2048x1536; color fundus image; 45° field of view — 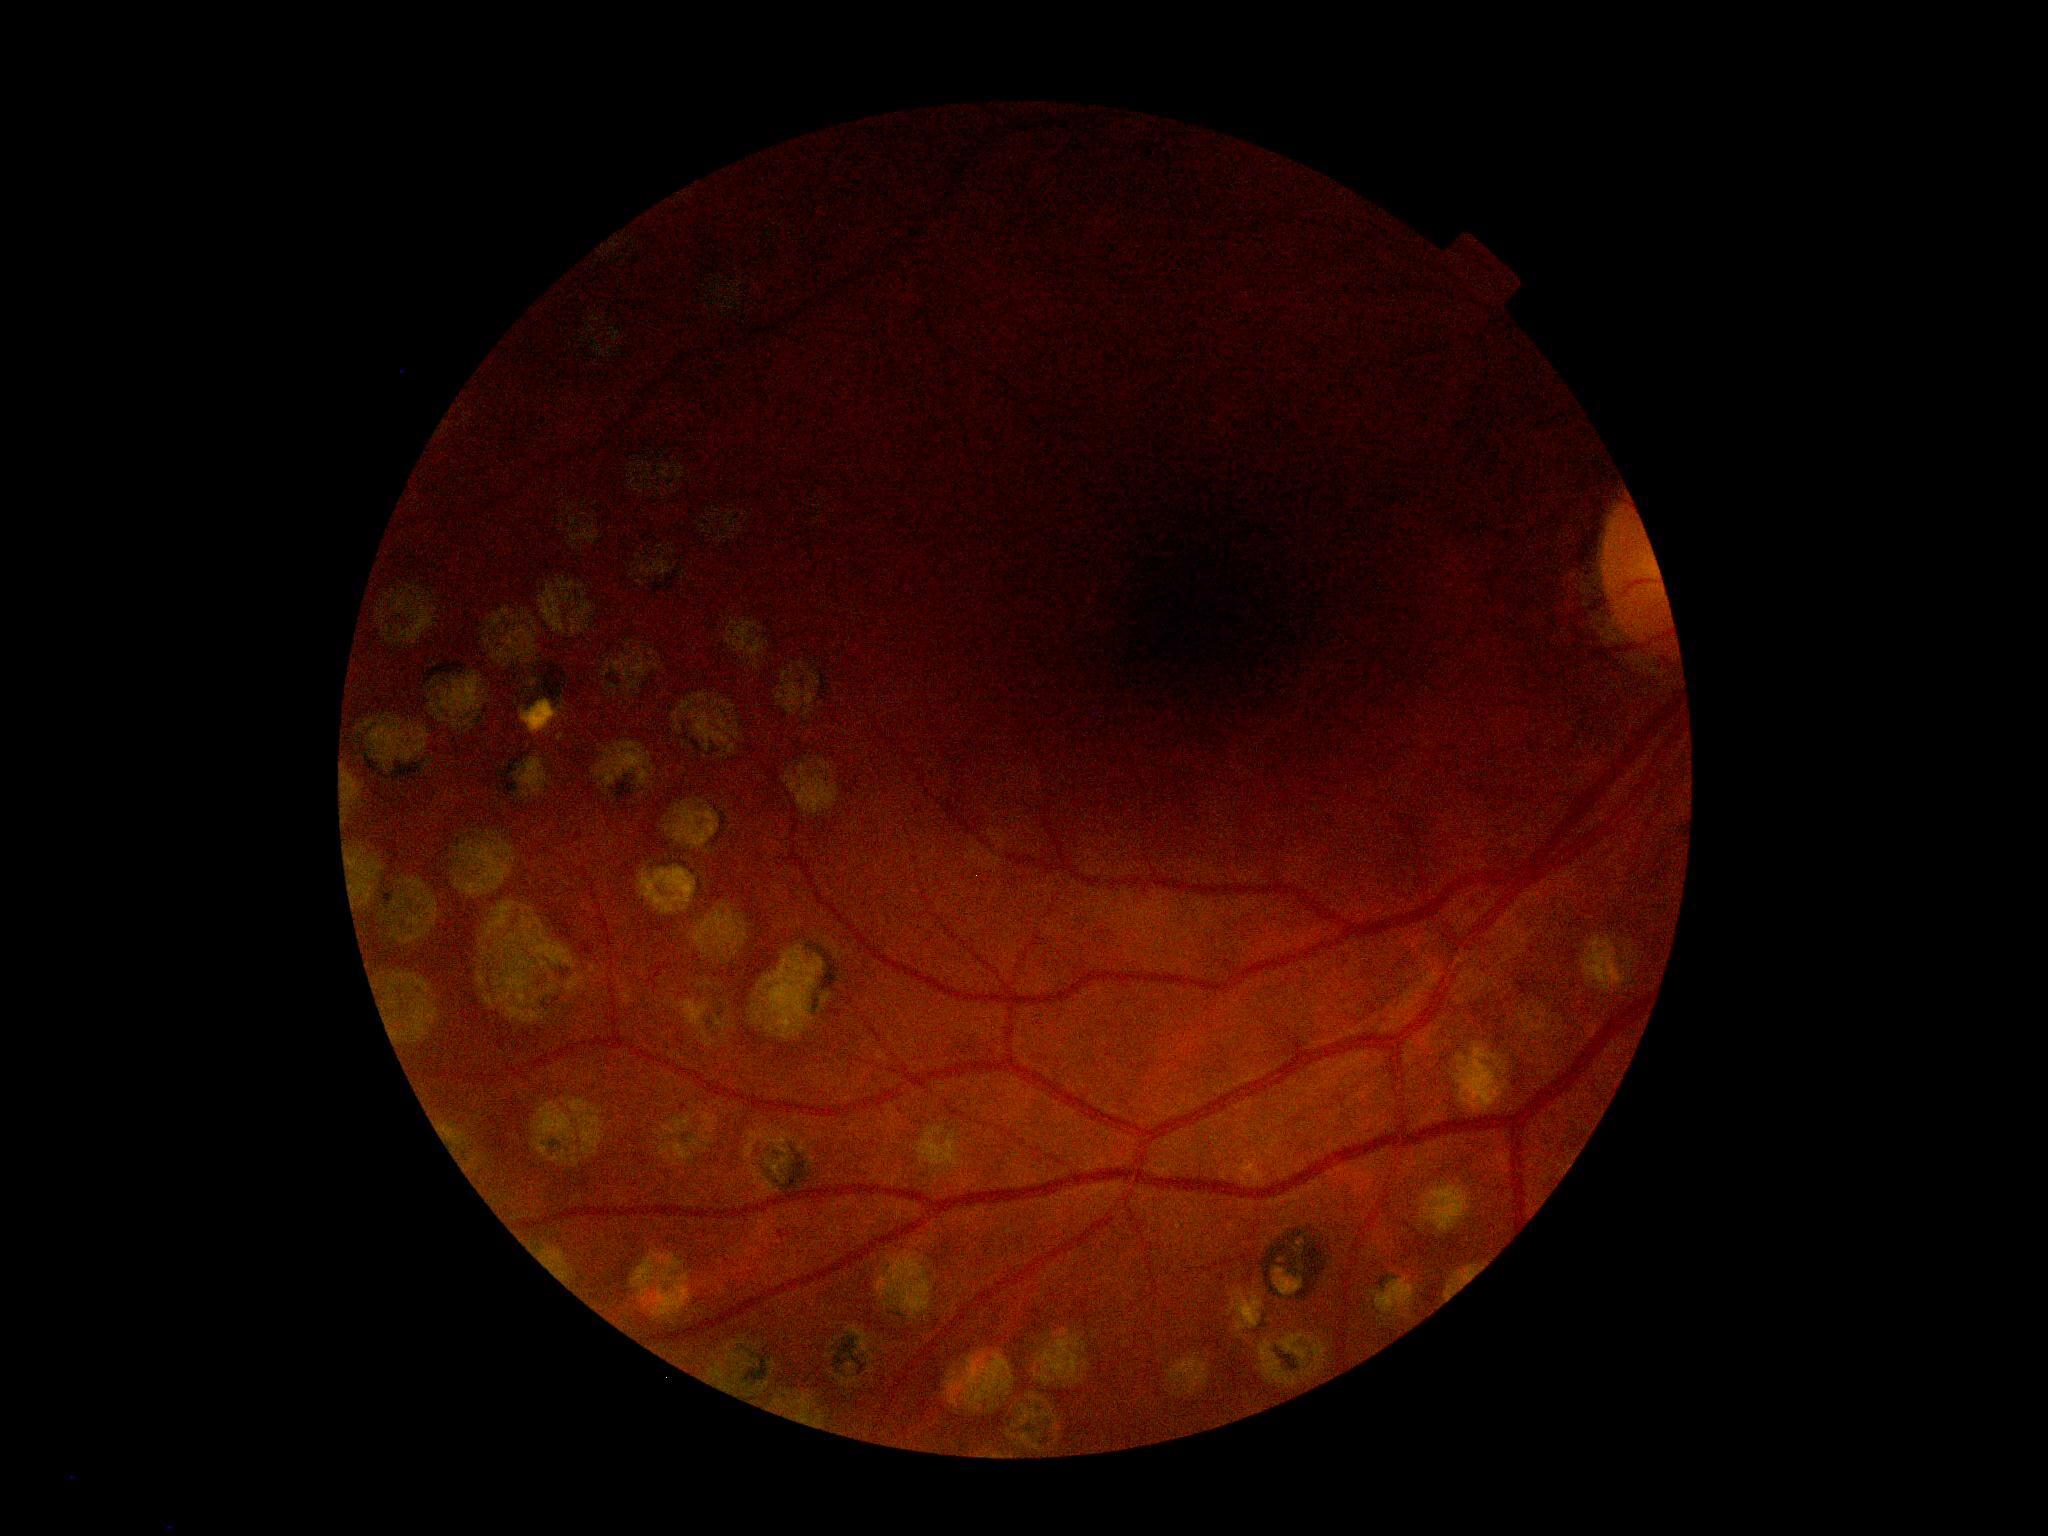

DR severity: 2/4 — more than just microaneurysms but less than severe NPDR.